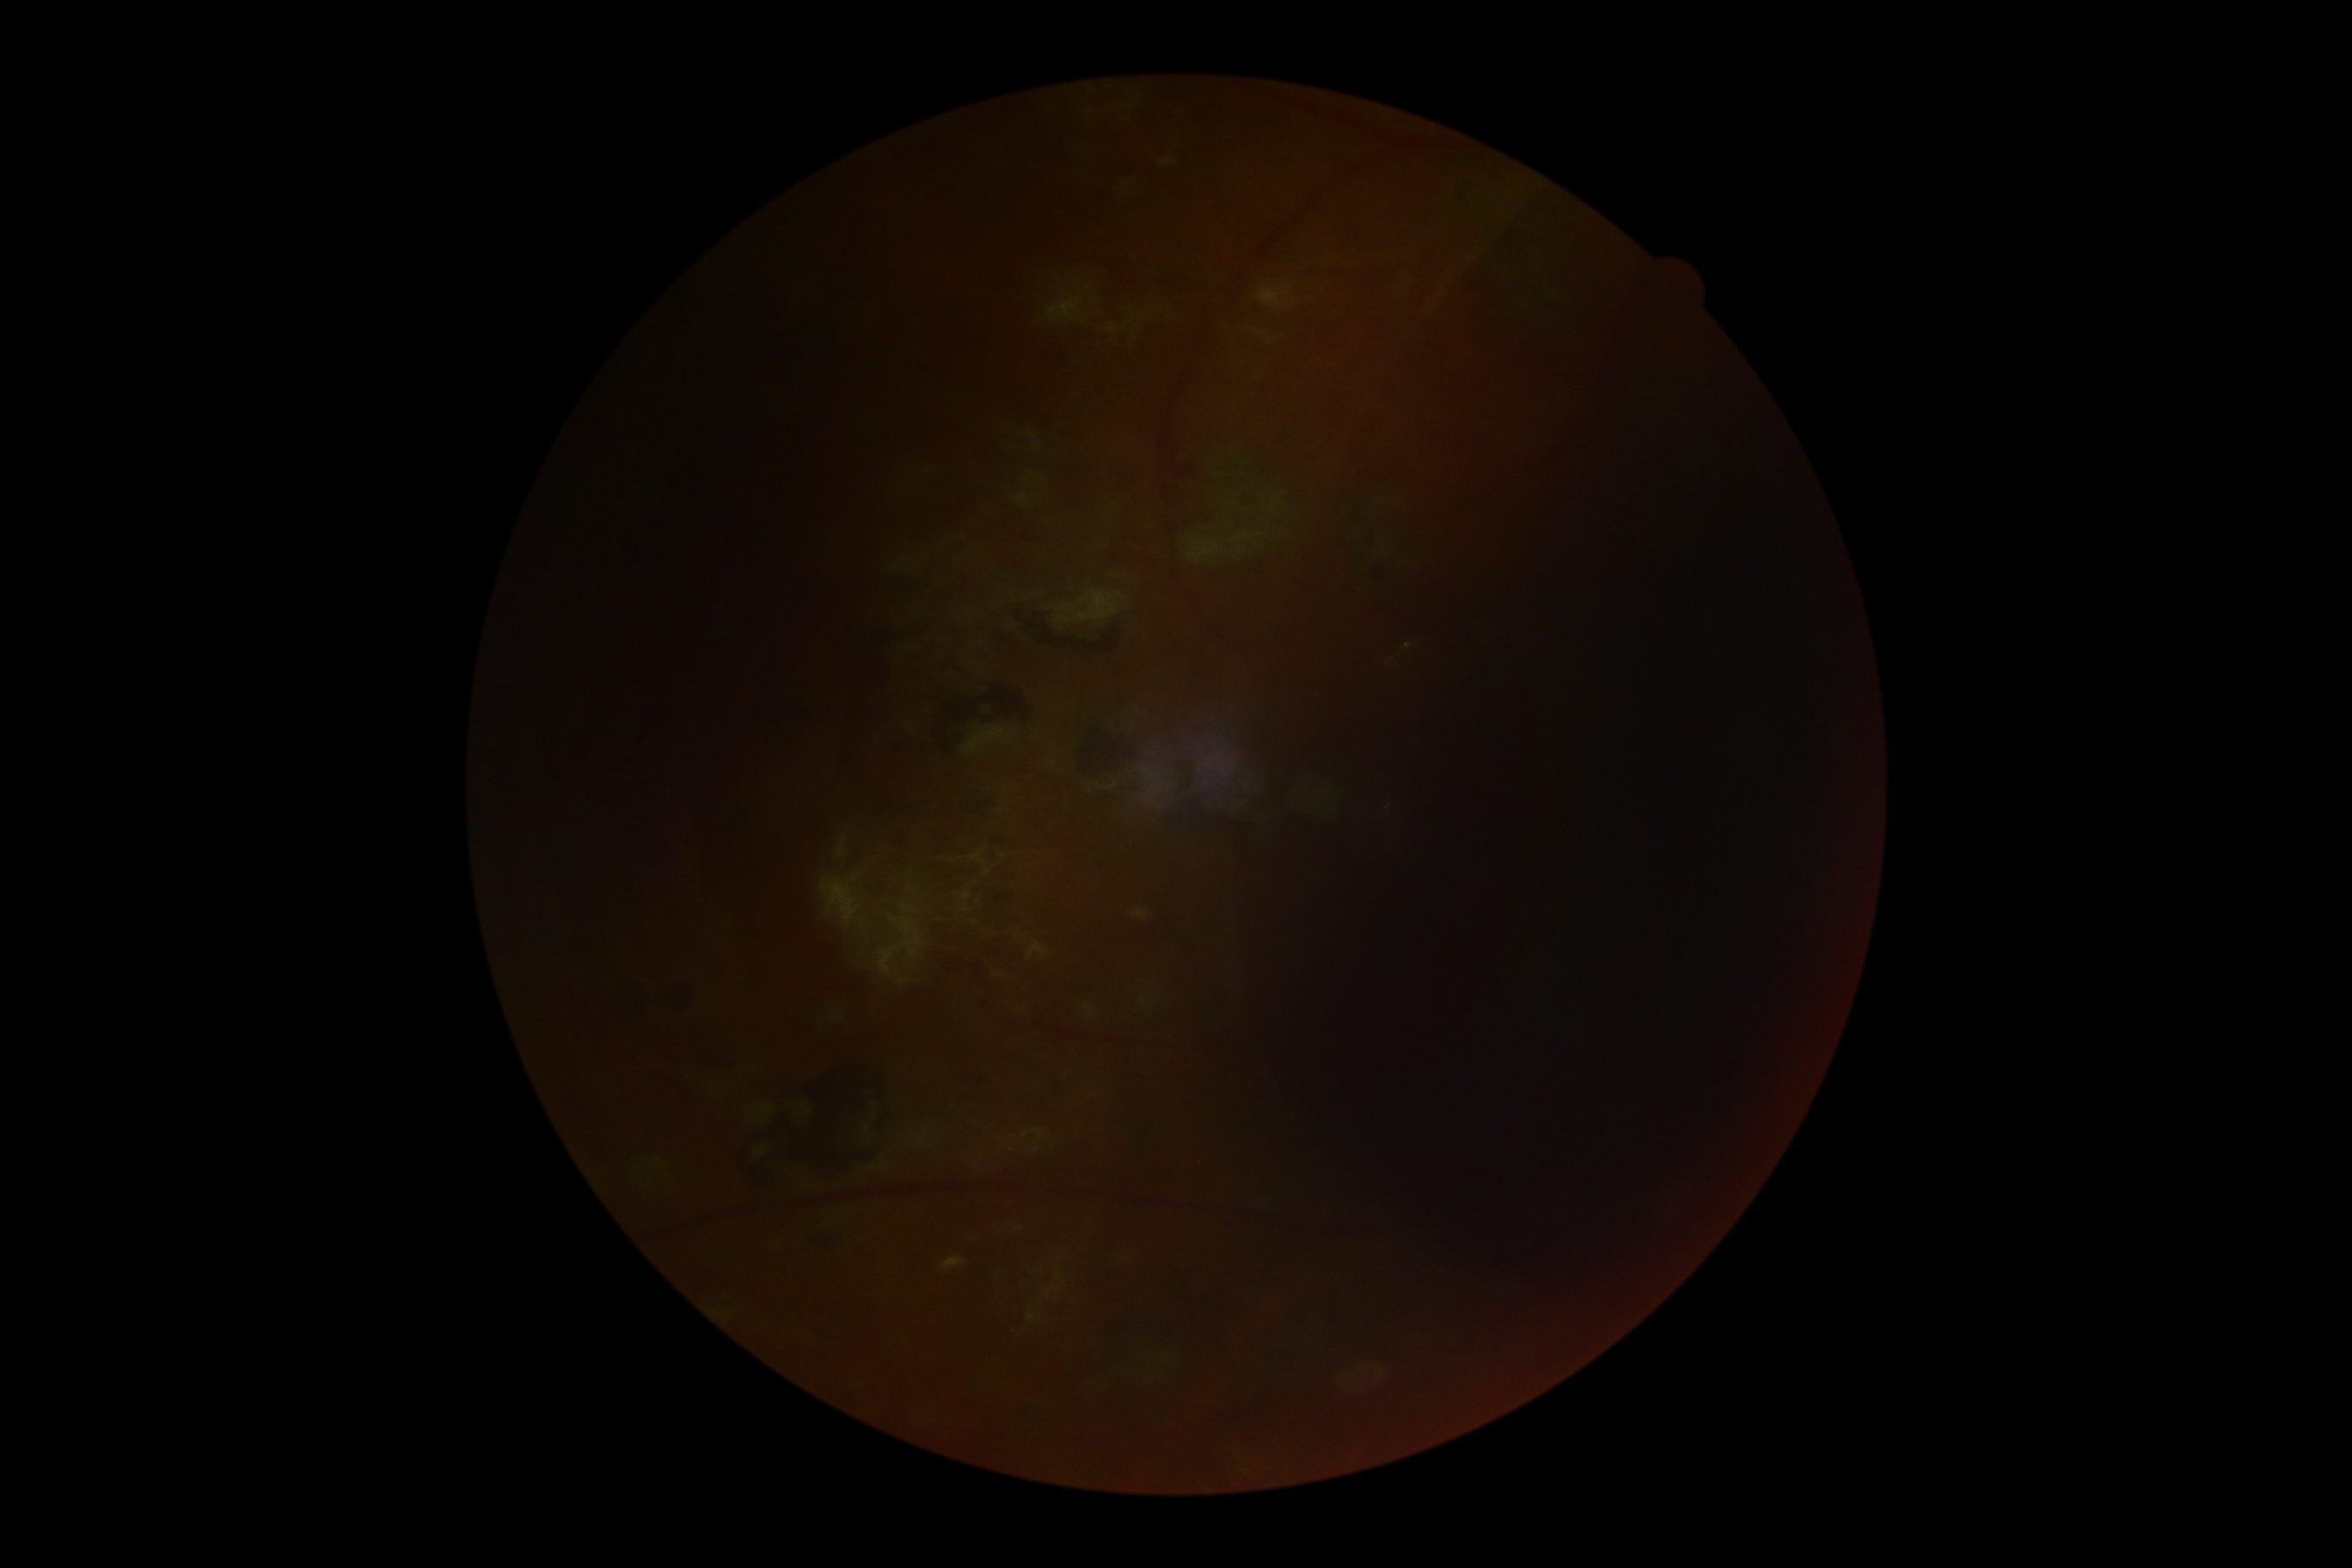 DR stage: ungradable due to poor image quality, image quality: too poor for DR grading.